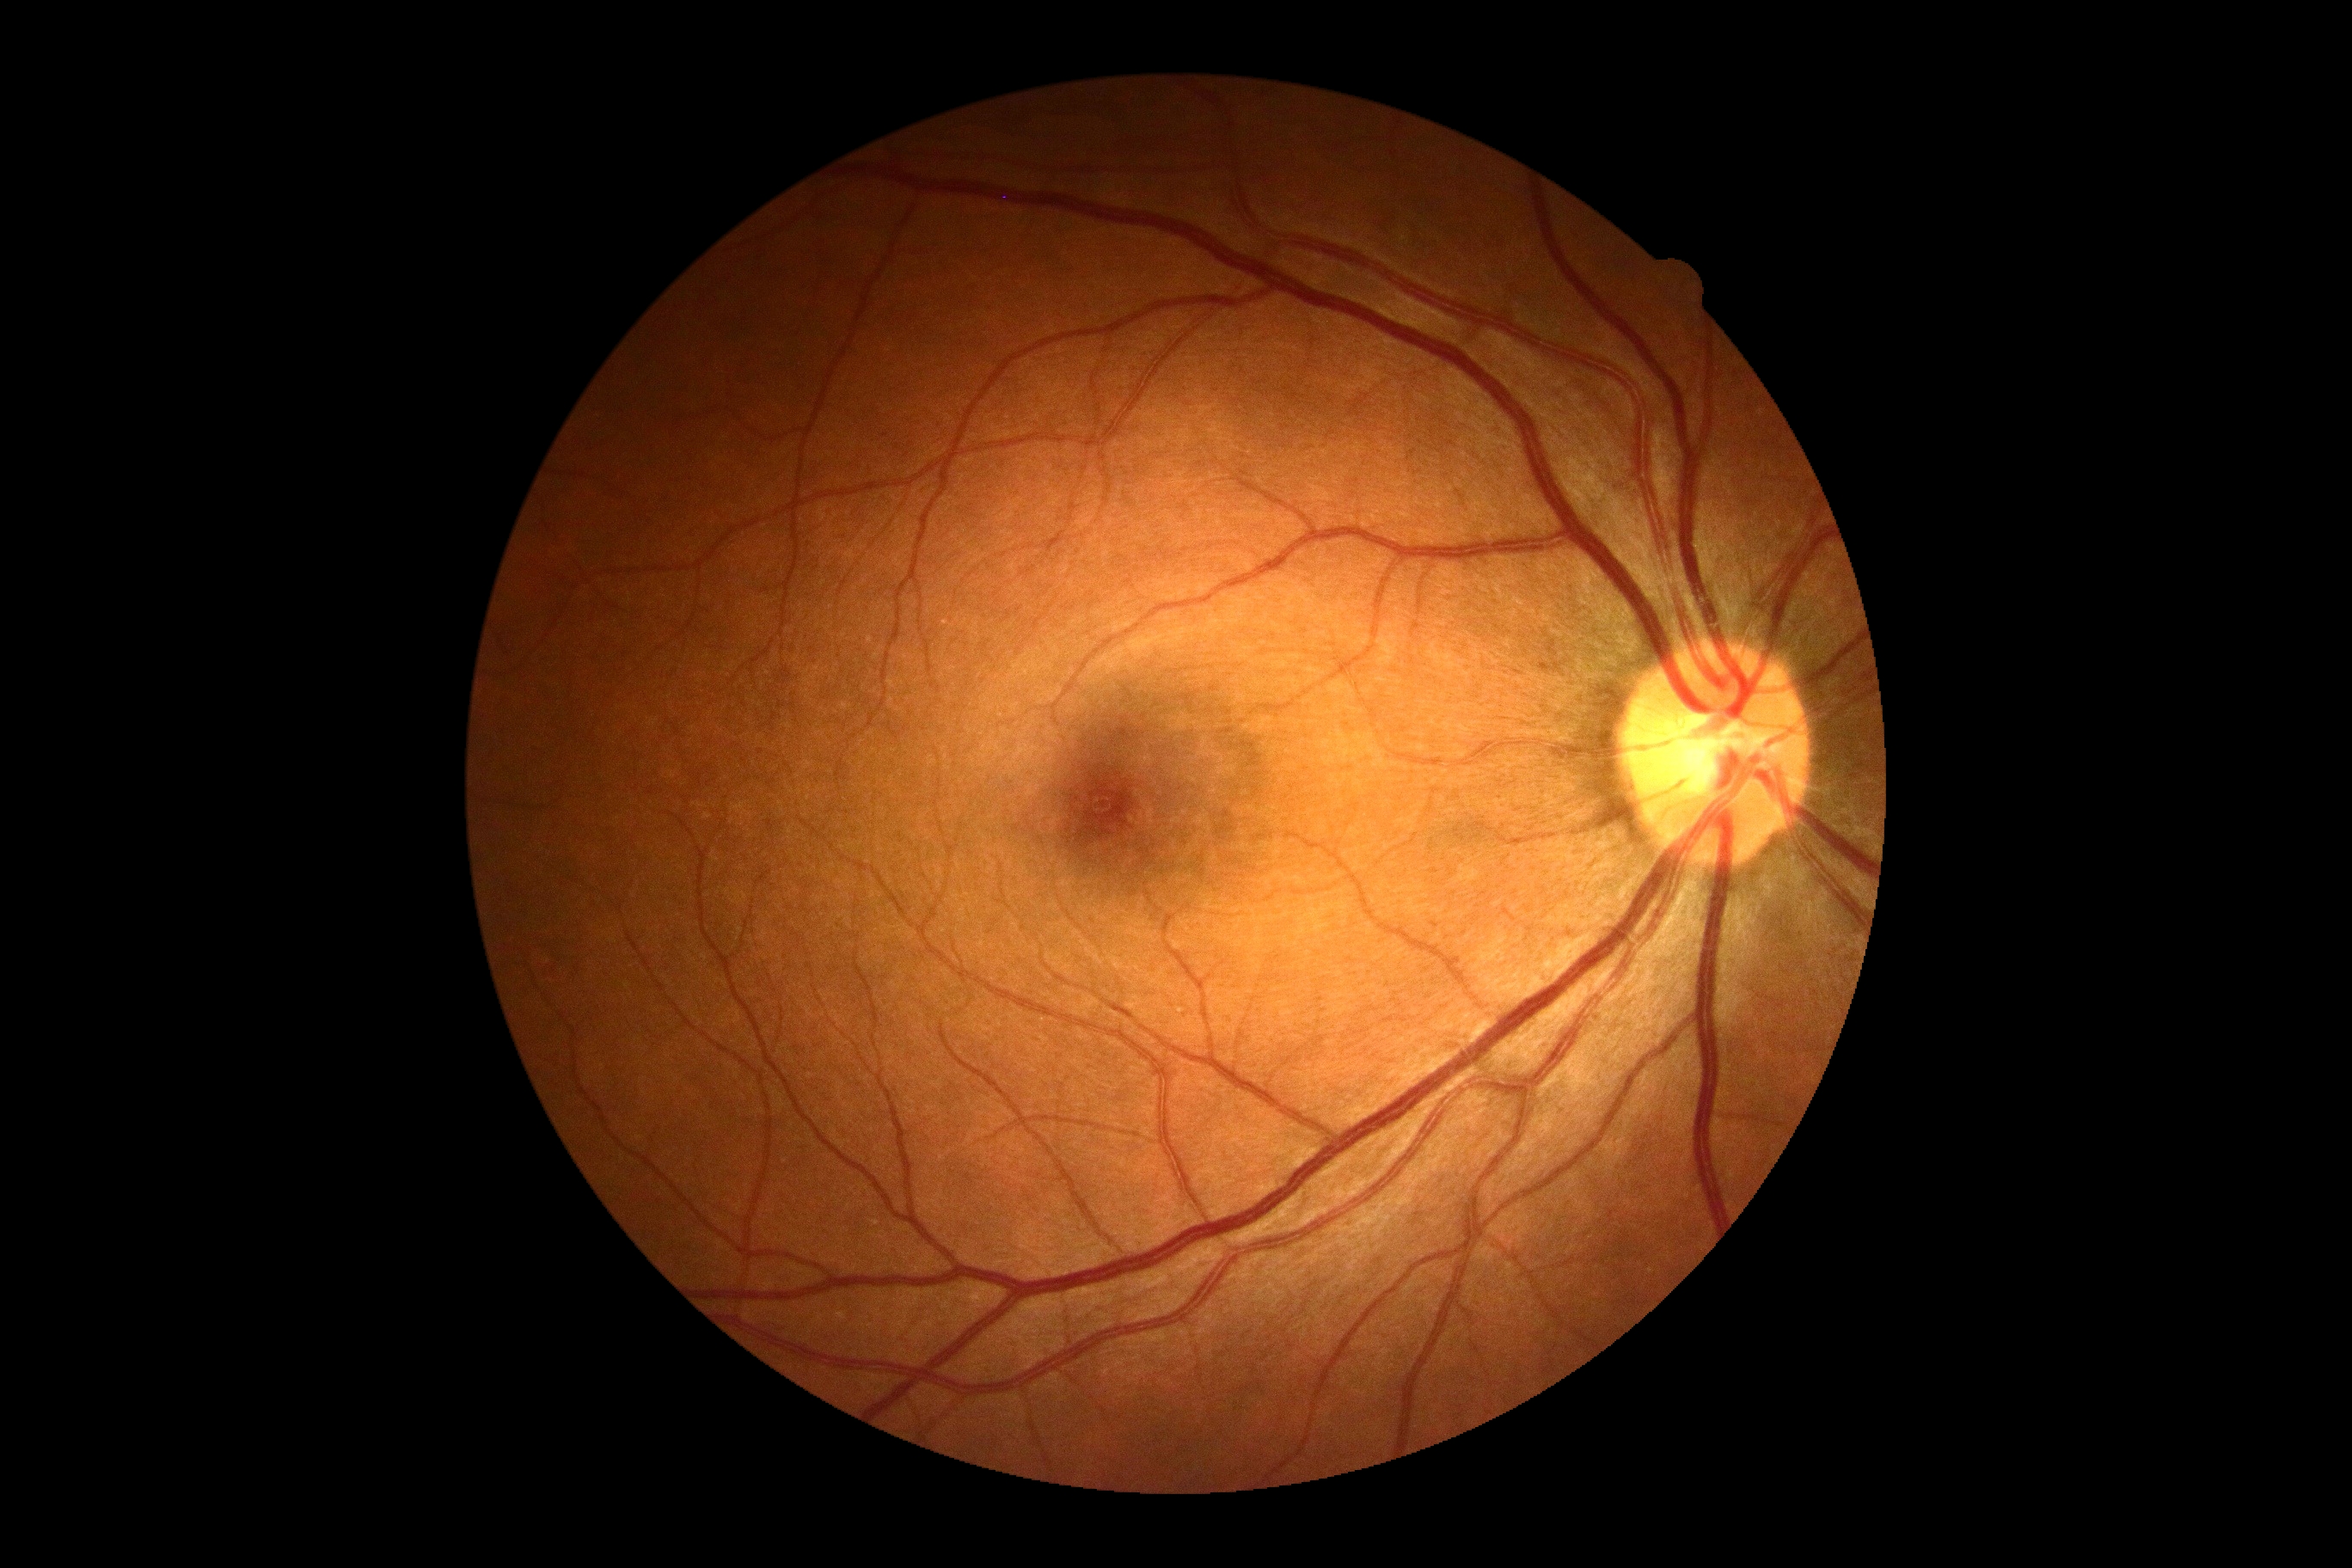
No diabetic retinal disease findings.
DR stage is no apparent retinopathy (grade 0).